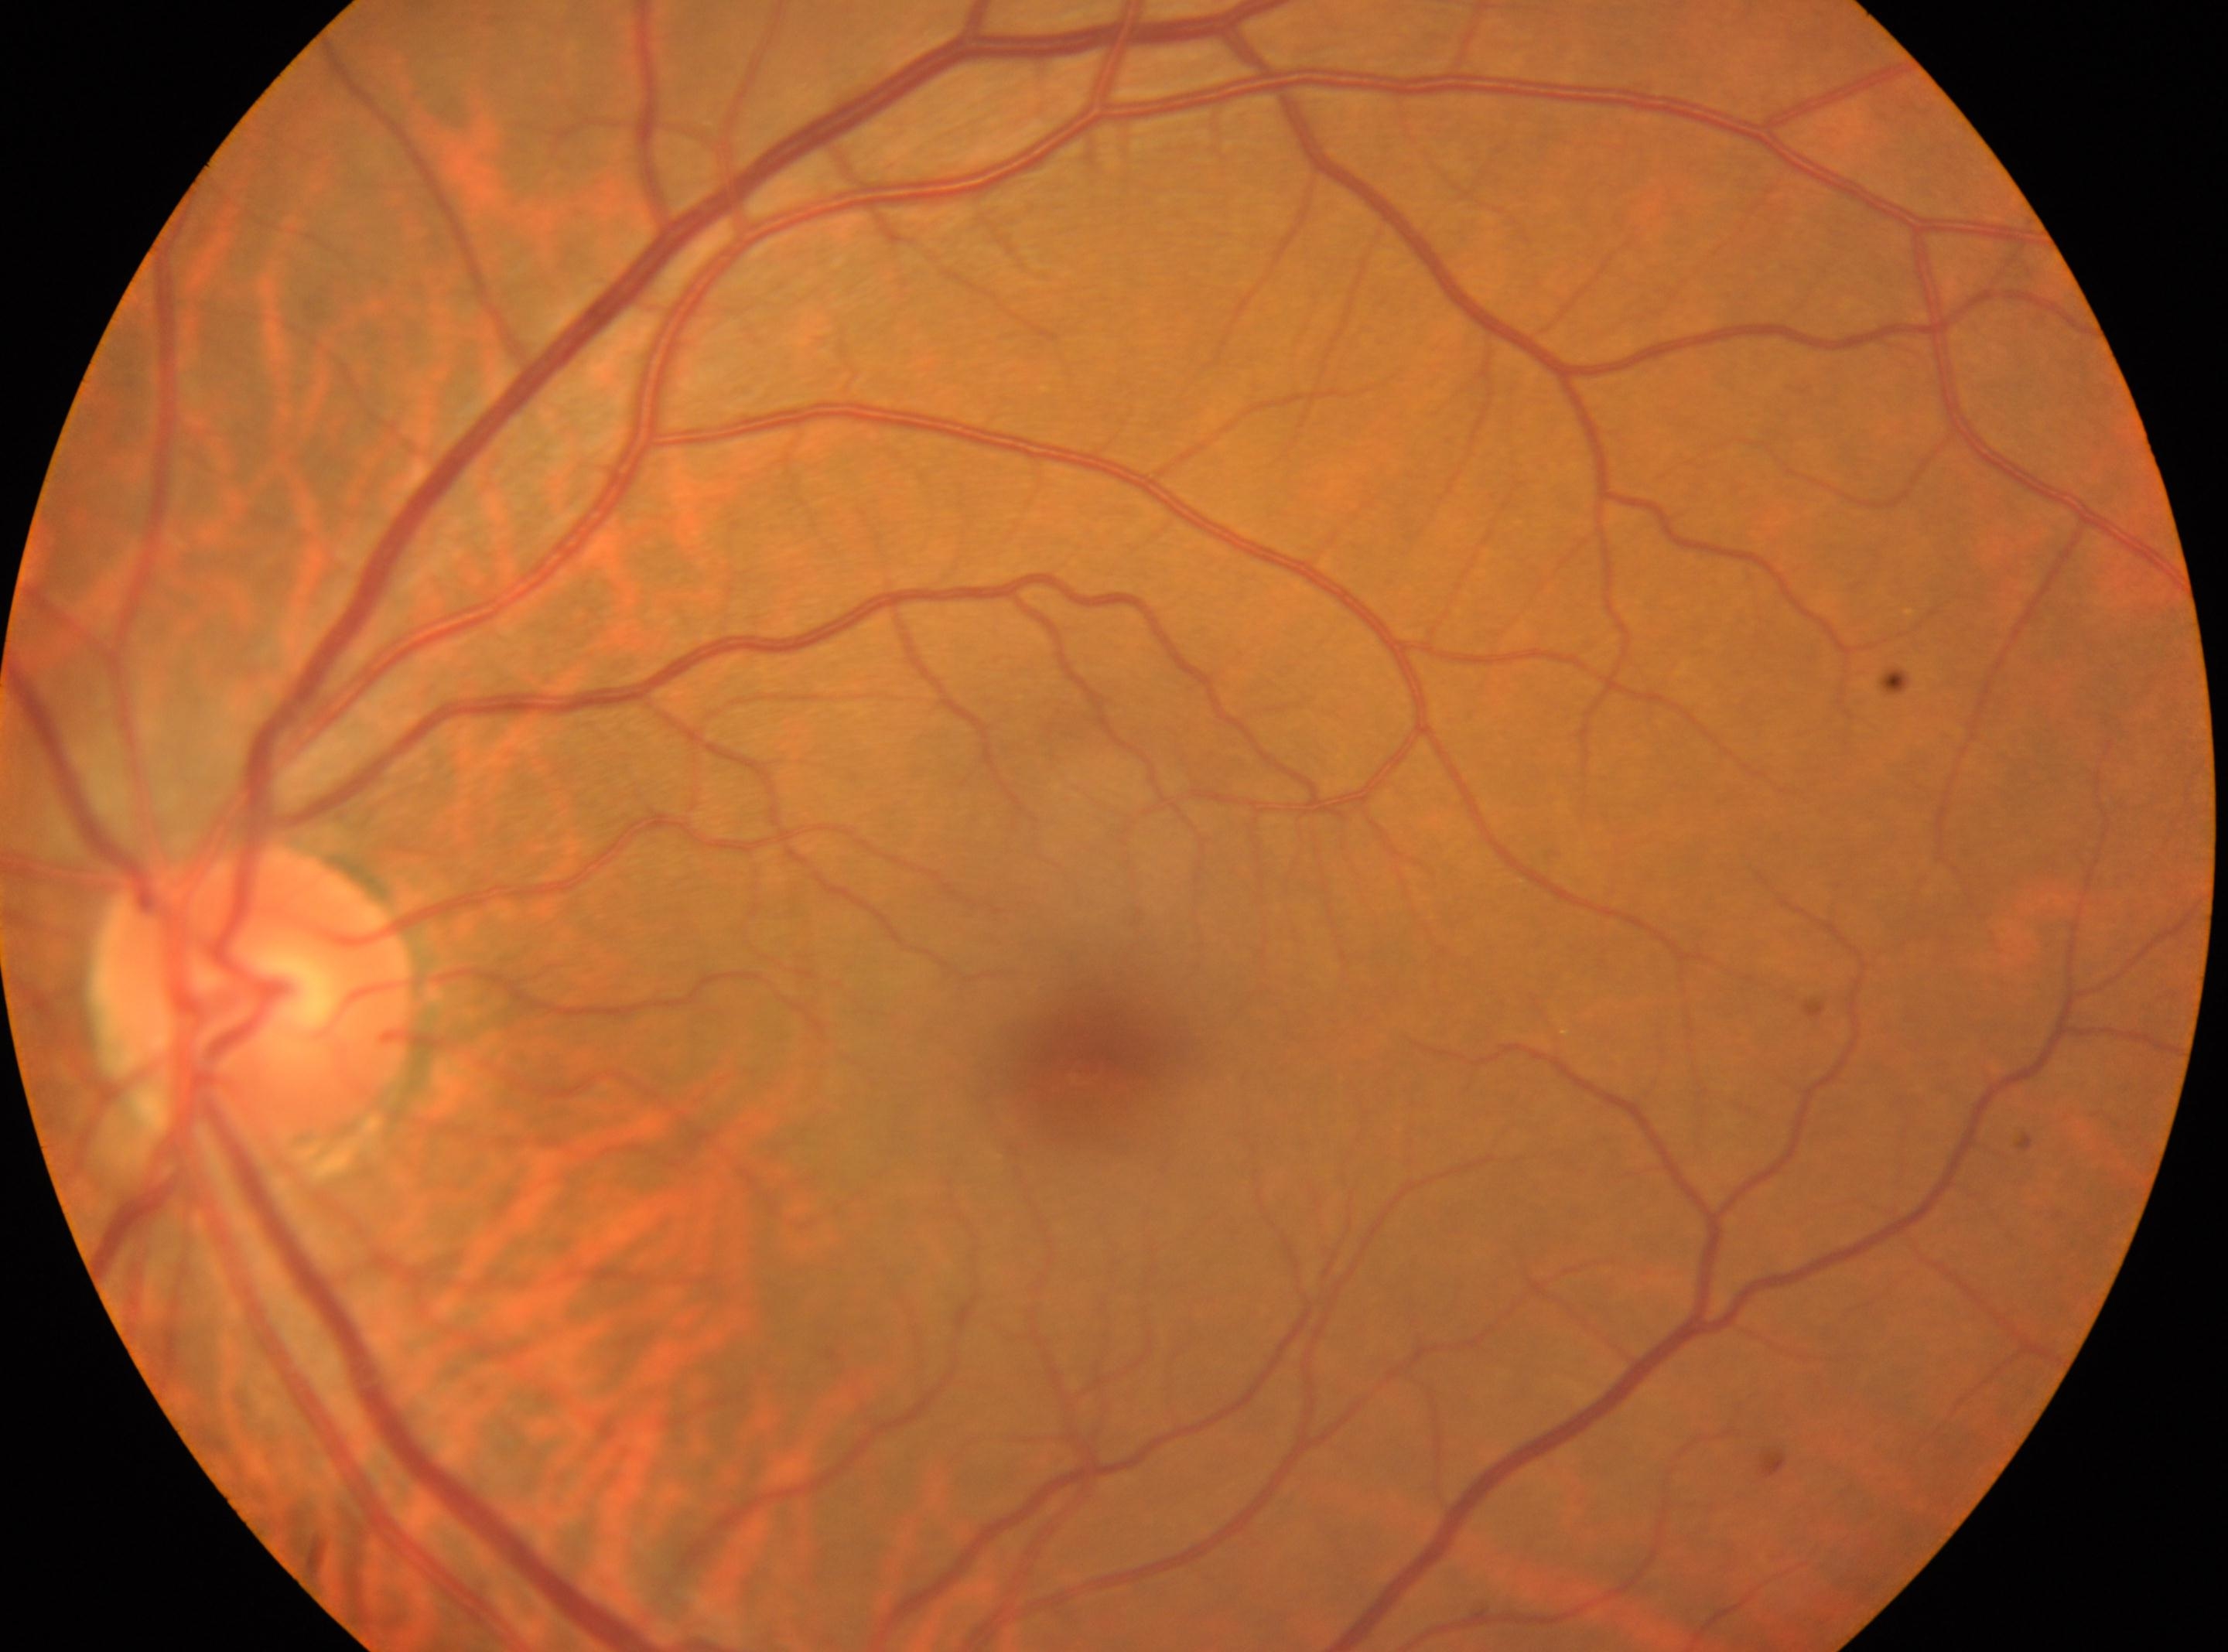

macular center = (1094,1072), laterality = left eye, diabetic retinopathy (DR) = 0/4, the optic disc = (254,999).